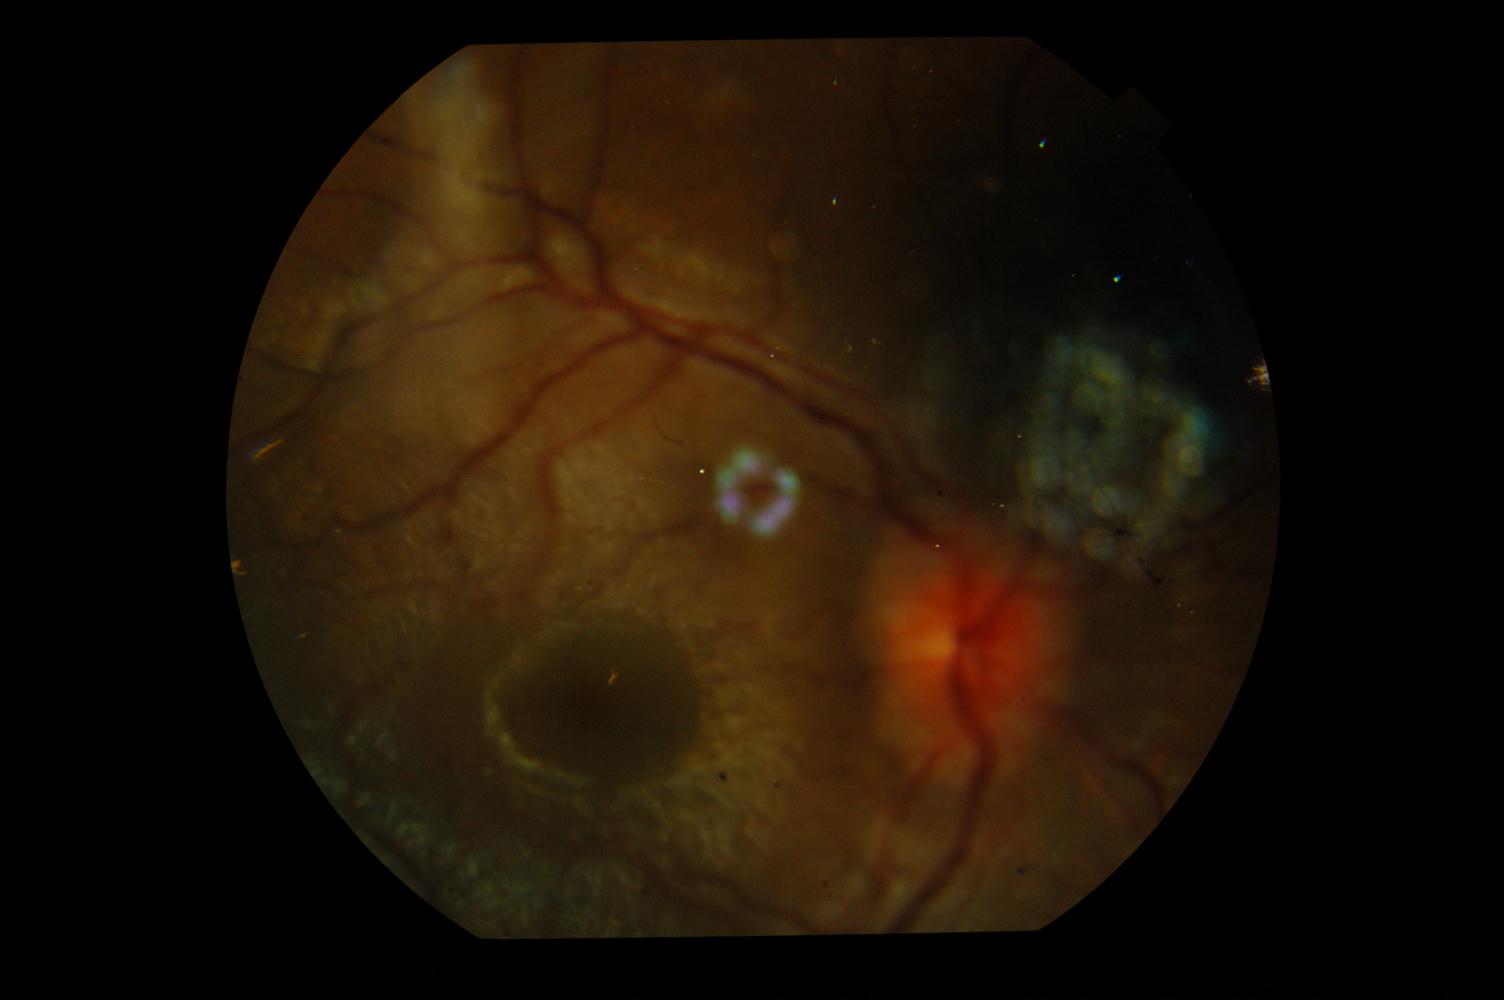
Fundus appearance consistent with idiopathic intracranial hypertension.